Color fundus photograph · intraocular pressure (IOP): 23 mmHg — 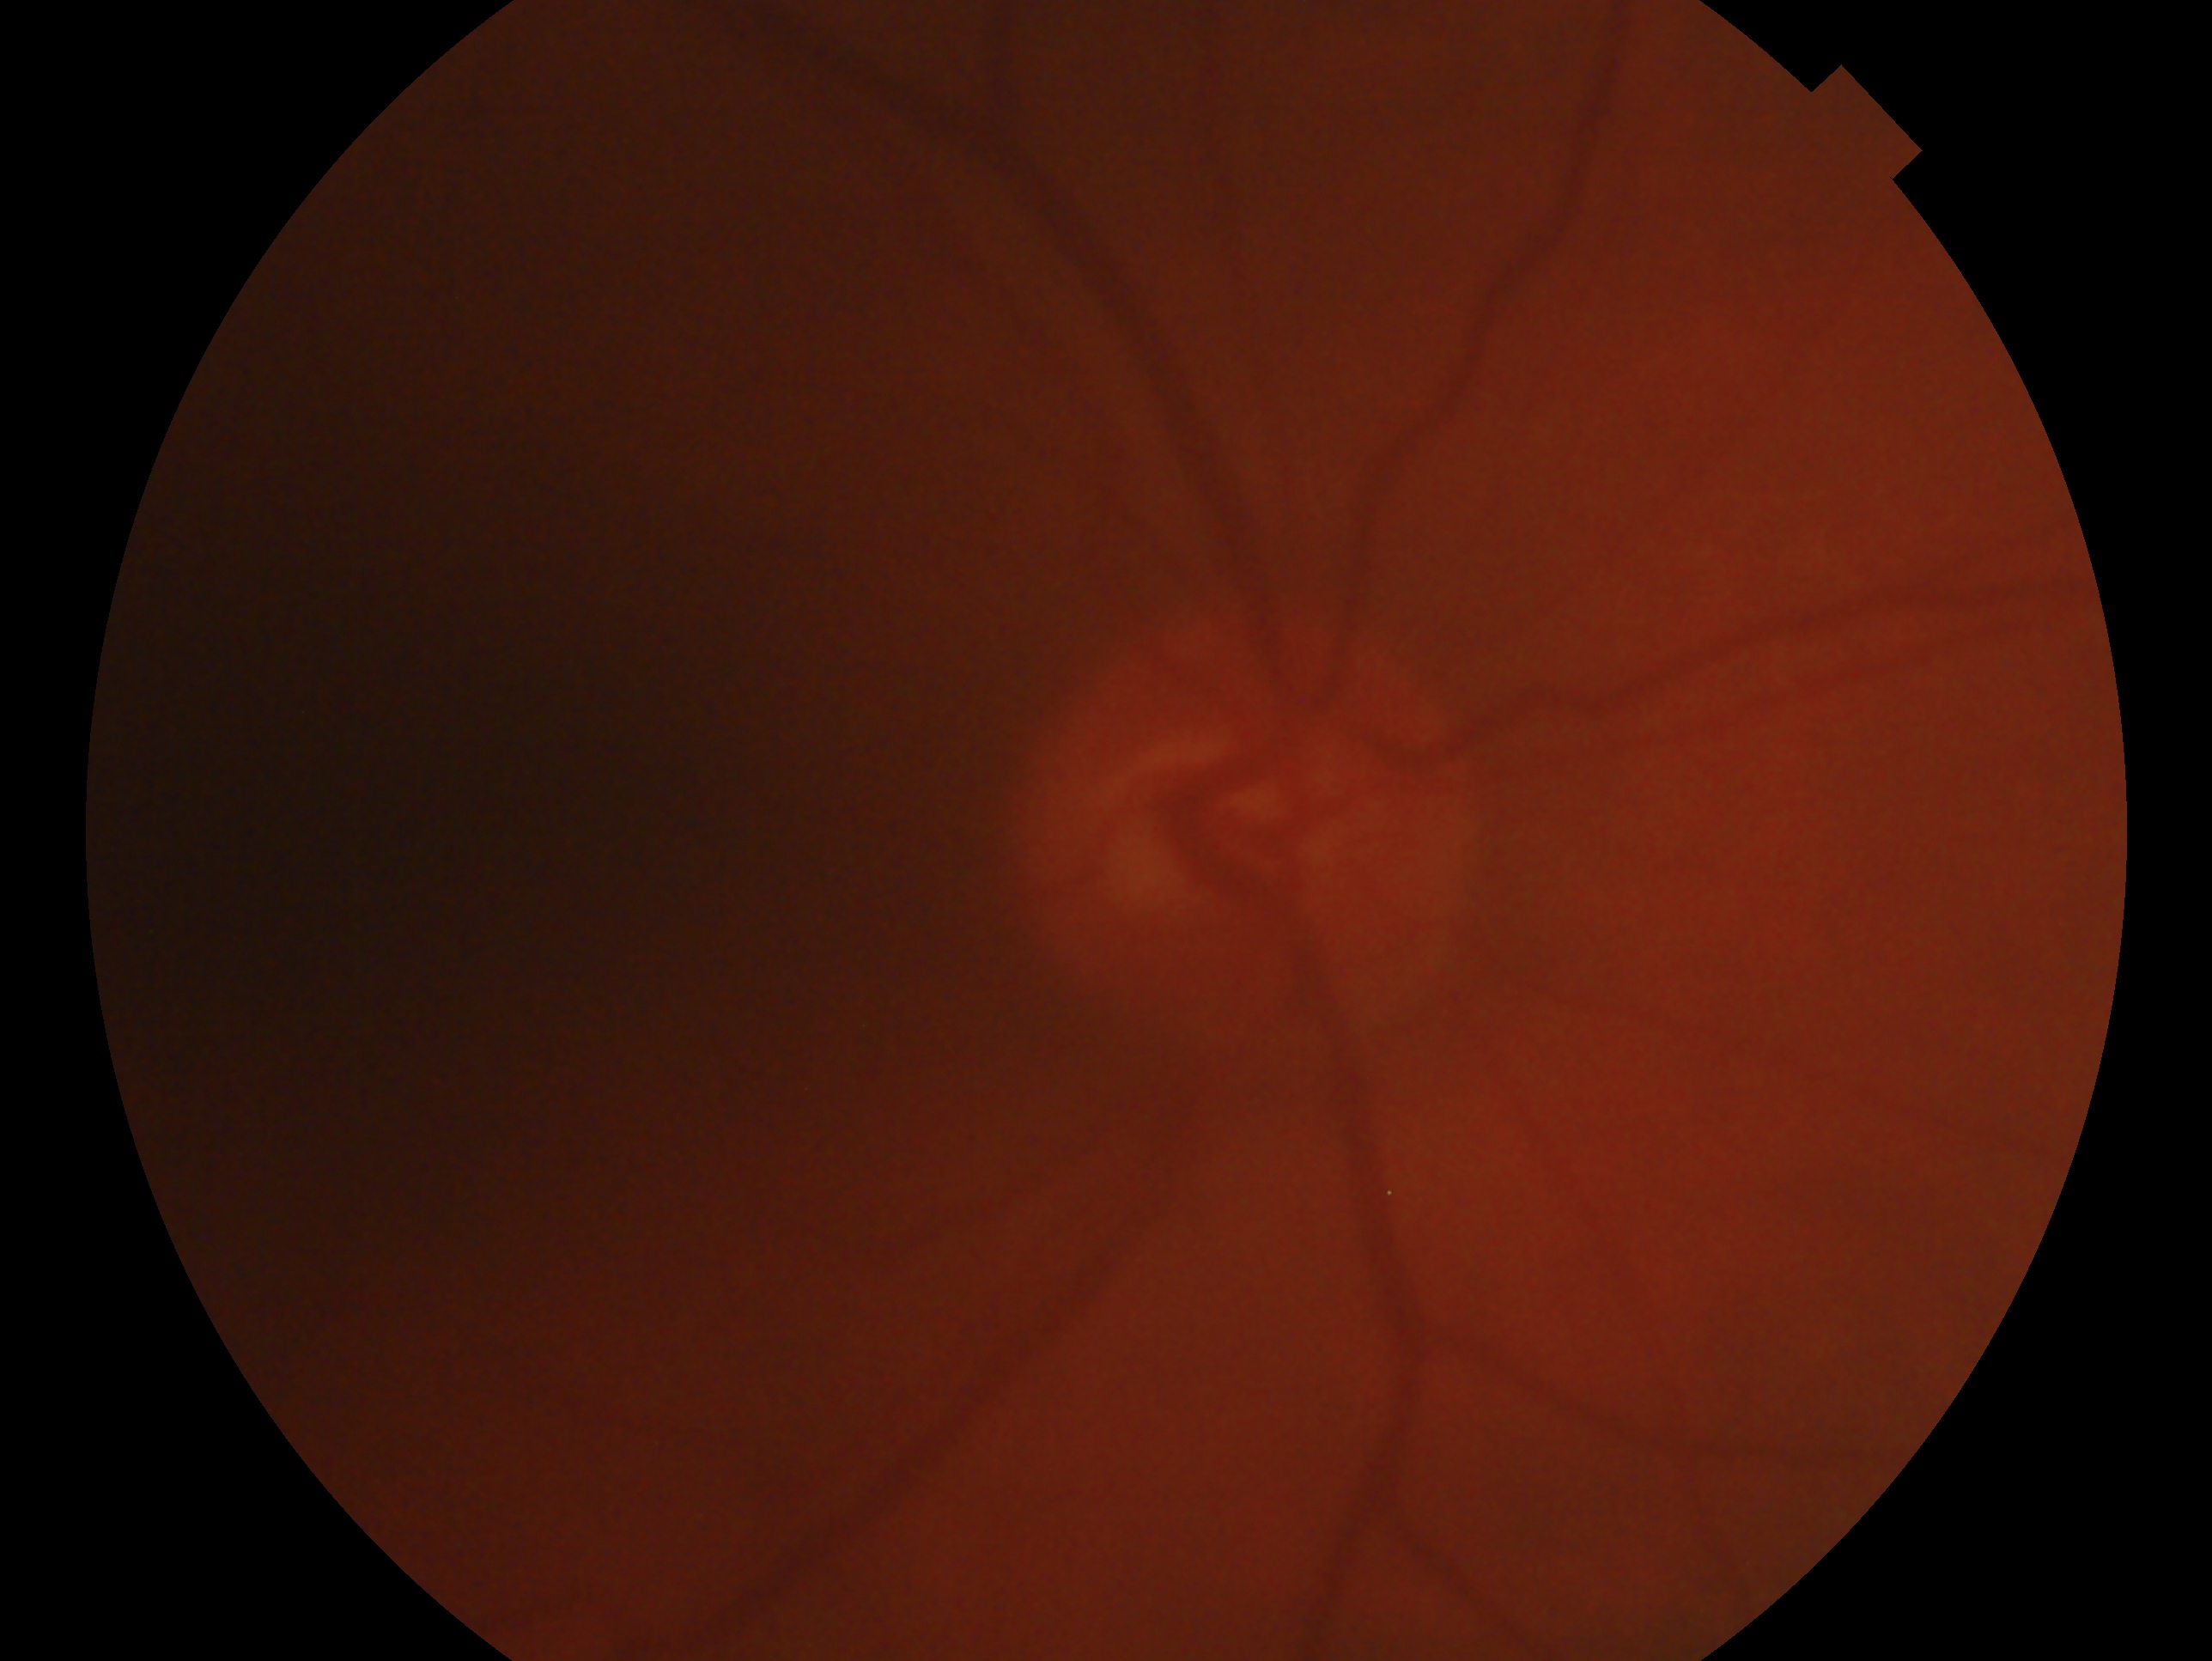

This is the oculus dexter. Glaucoma diagnosis: suspicious for glaucoma.